640 x 480 pixels; pediatric retinal photograph (wide-field)
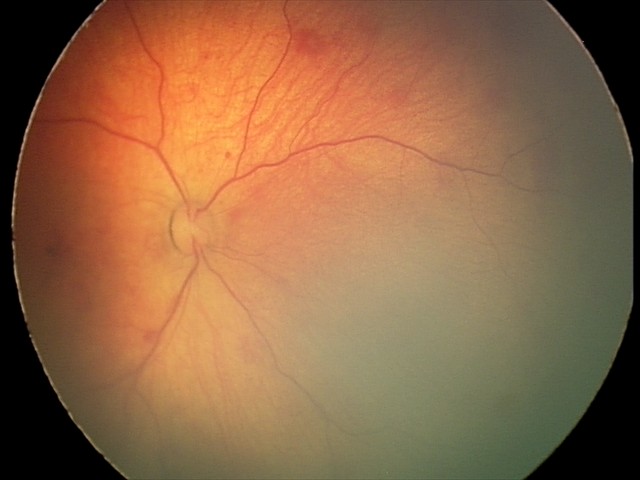

Q: What is the screening diagnosis?
A: retinal hemorrhages